Image size 2048x1536, retinal fundus photograph
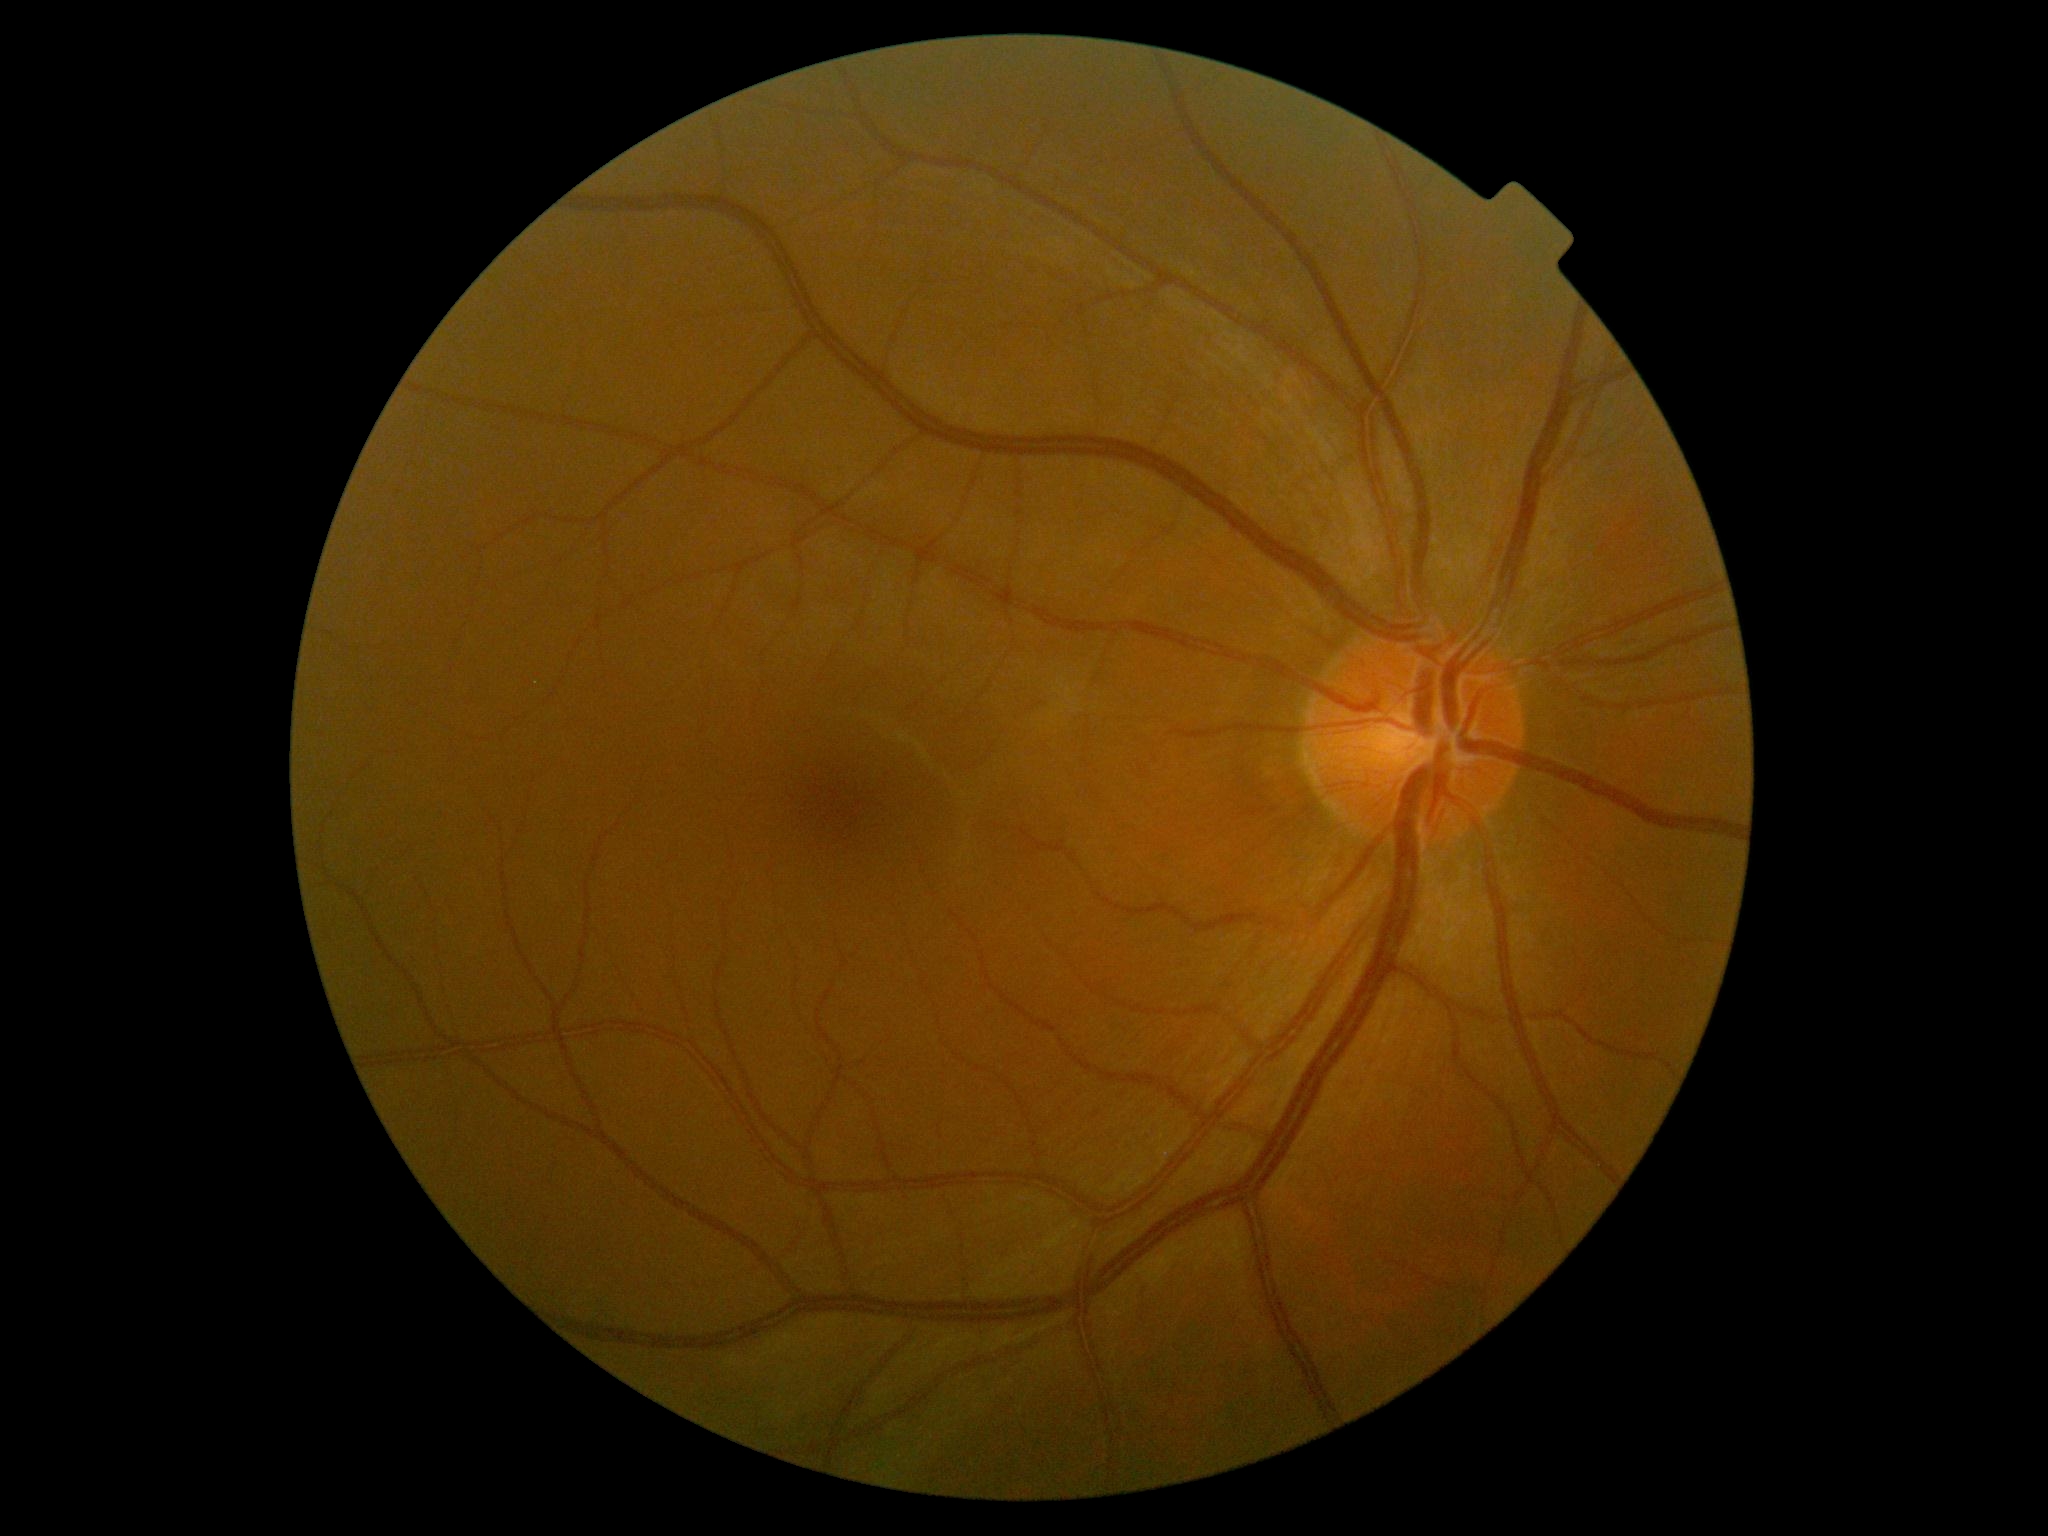 diabetic retinopathy (DR) = 0.